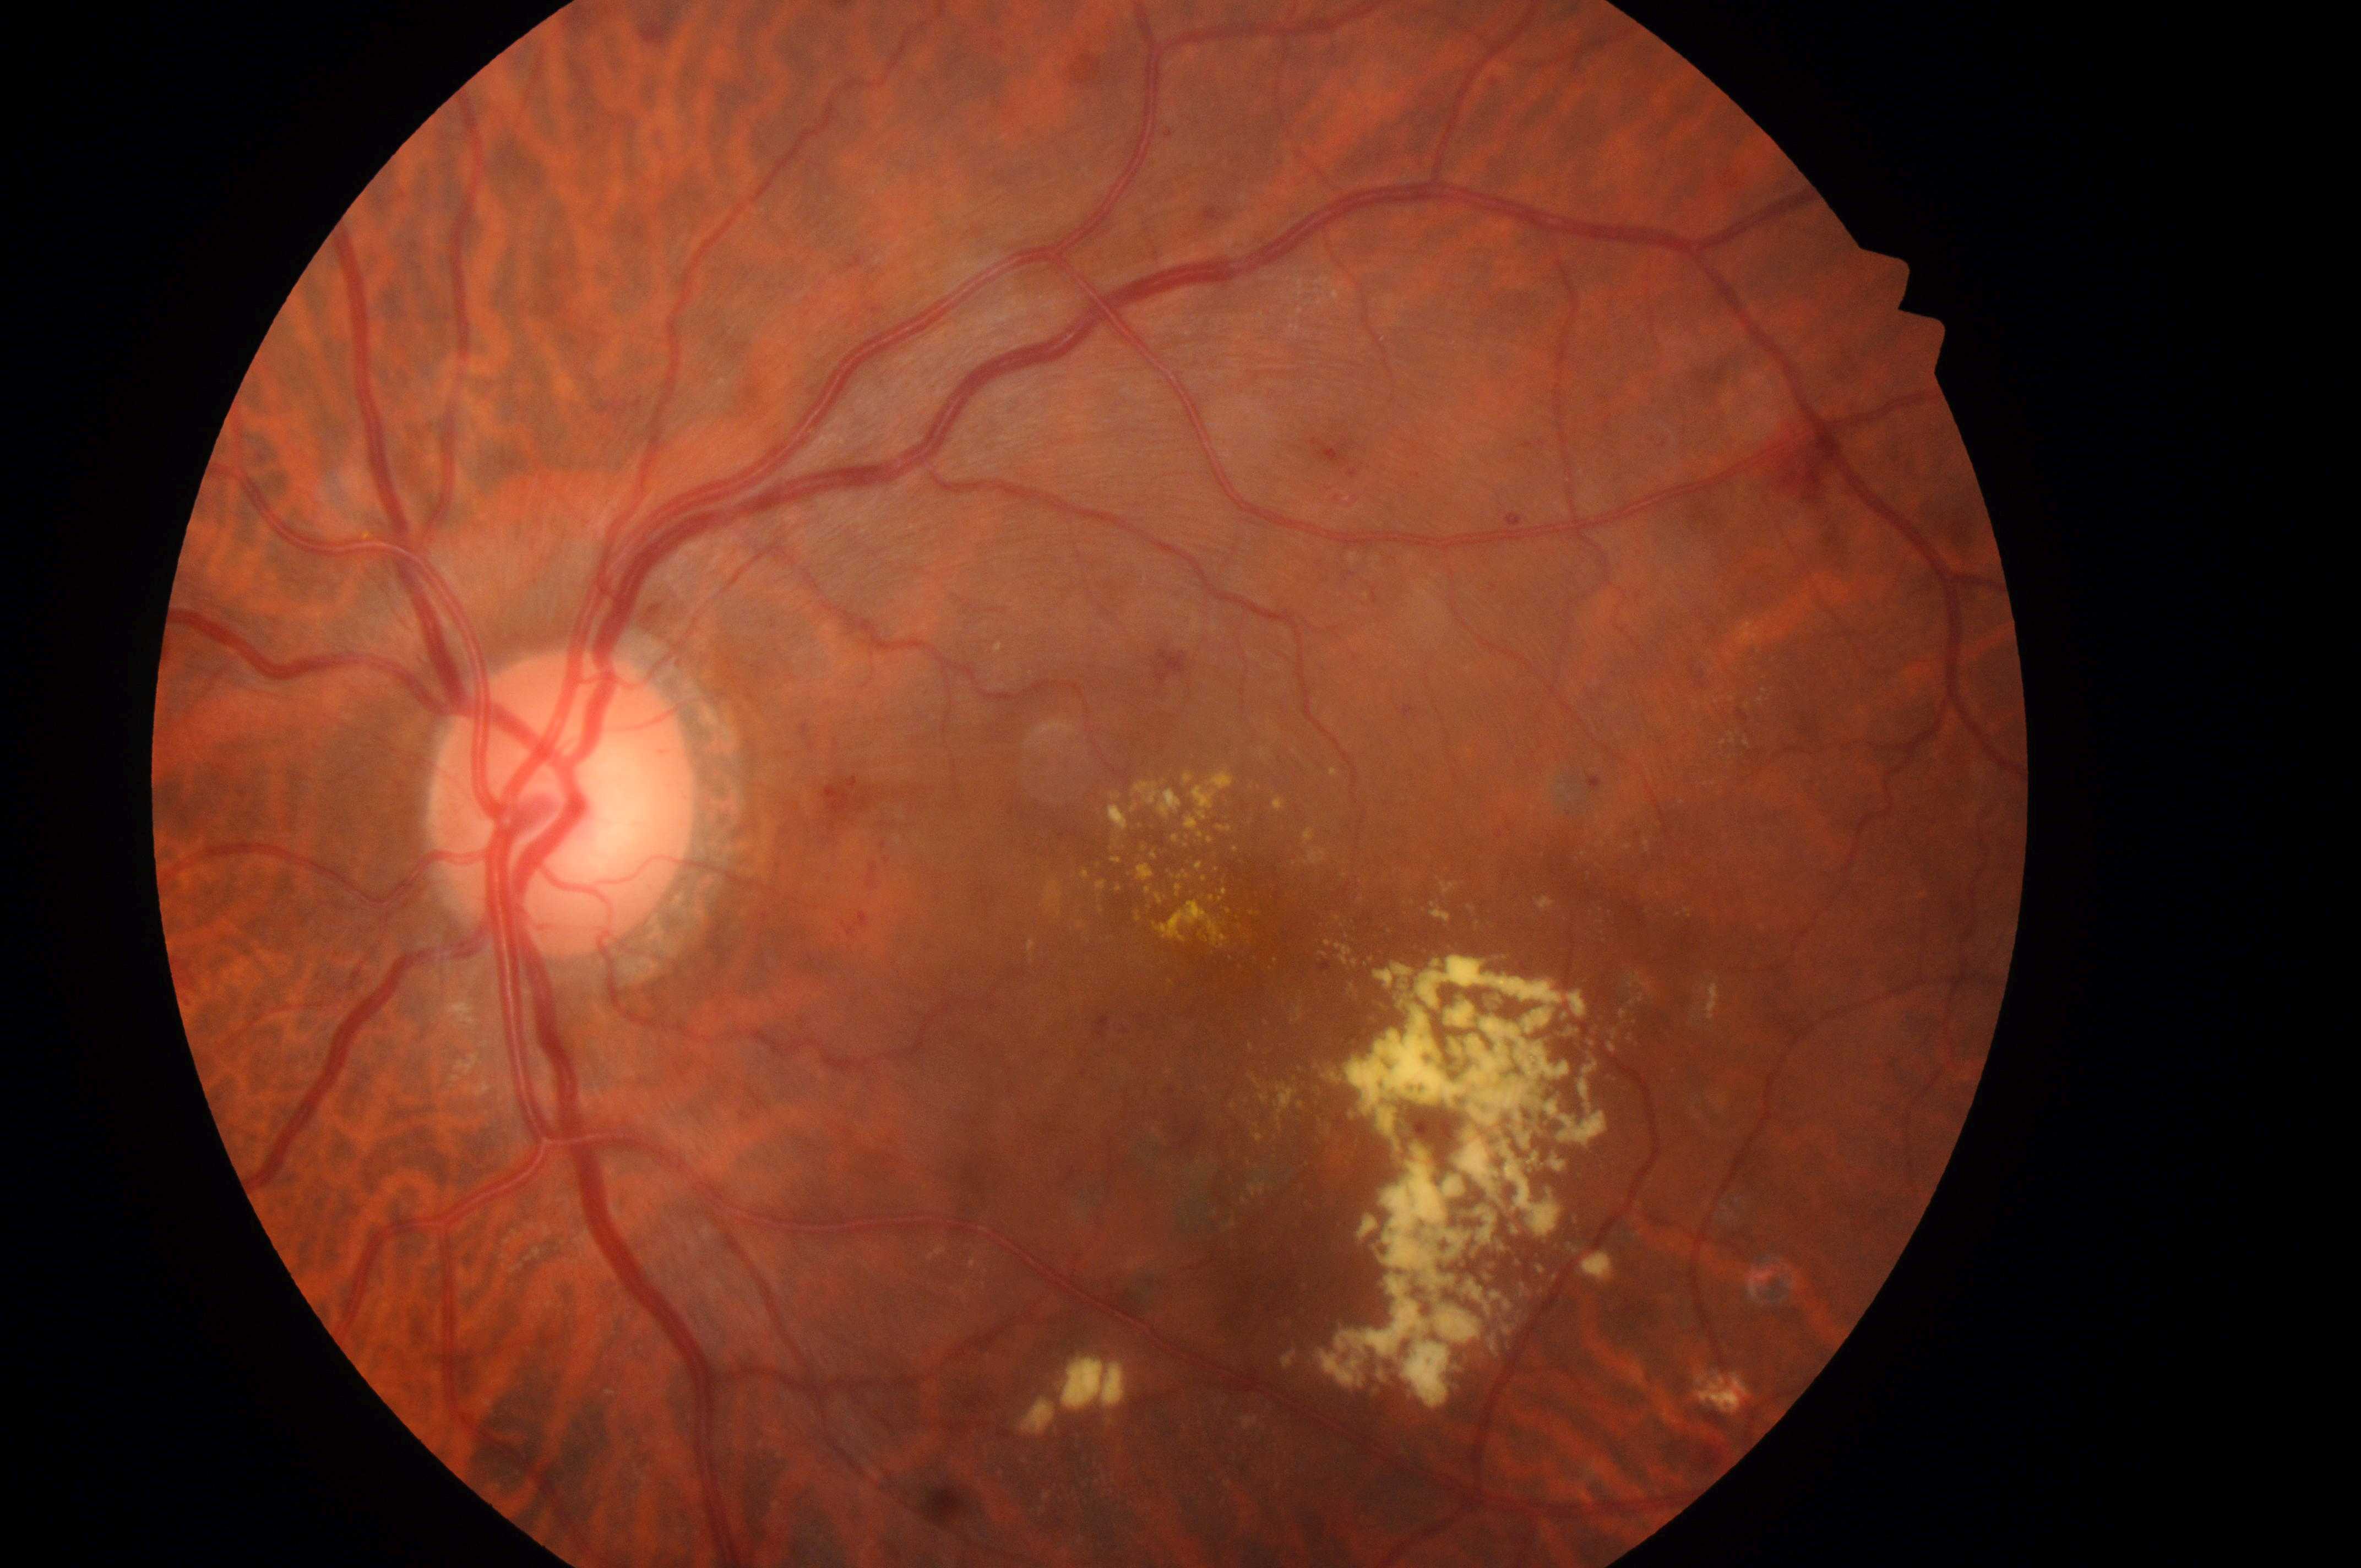   eye: left eye
  dme_grade: 2
  dr_grade: 2
  optic_disc: (x: 554, y: 816)
  fovea: (x: 1236, y: 928)